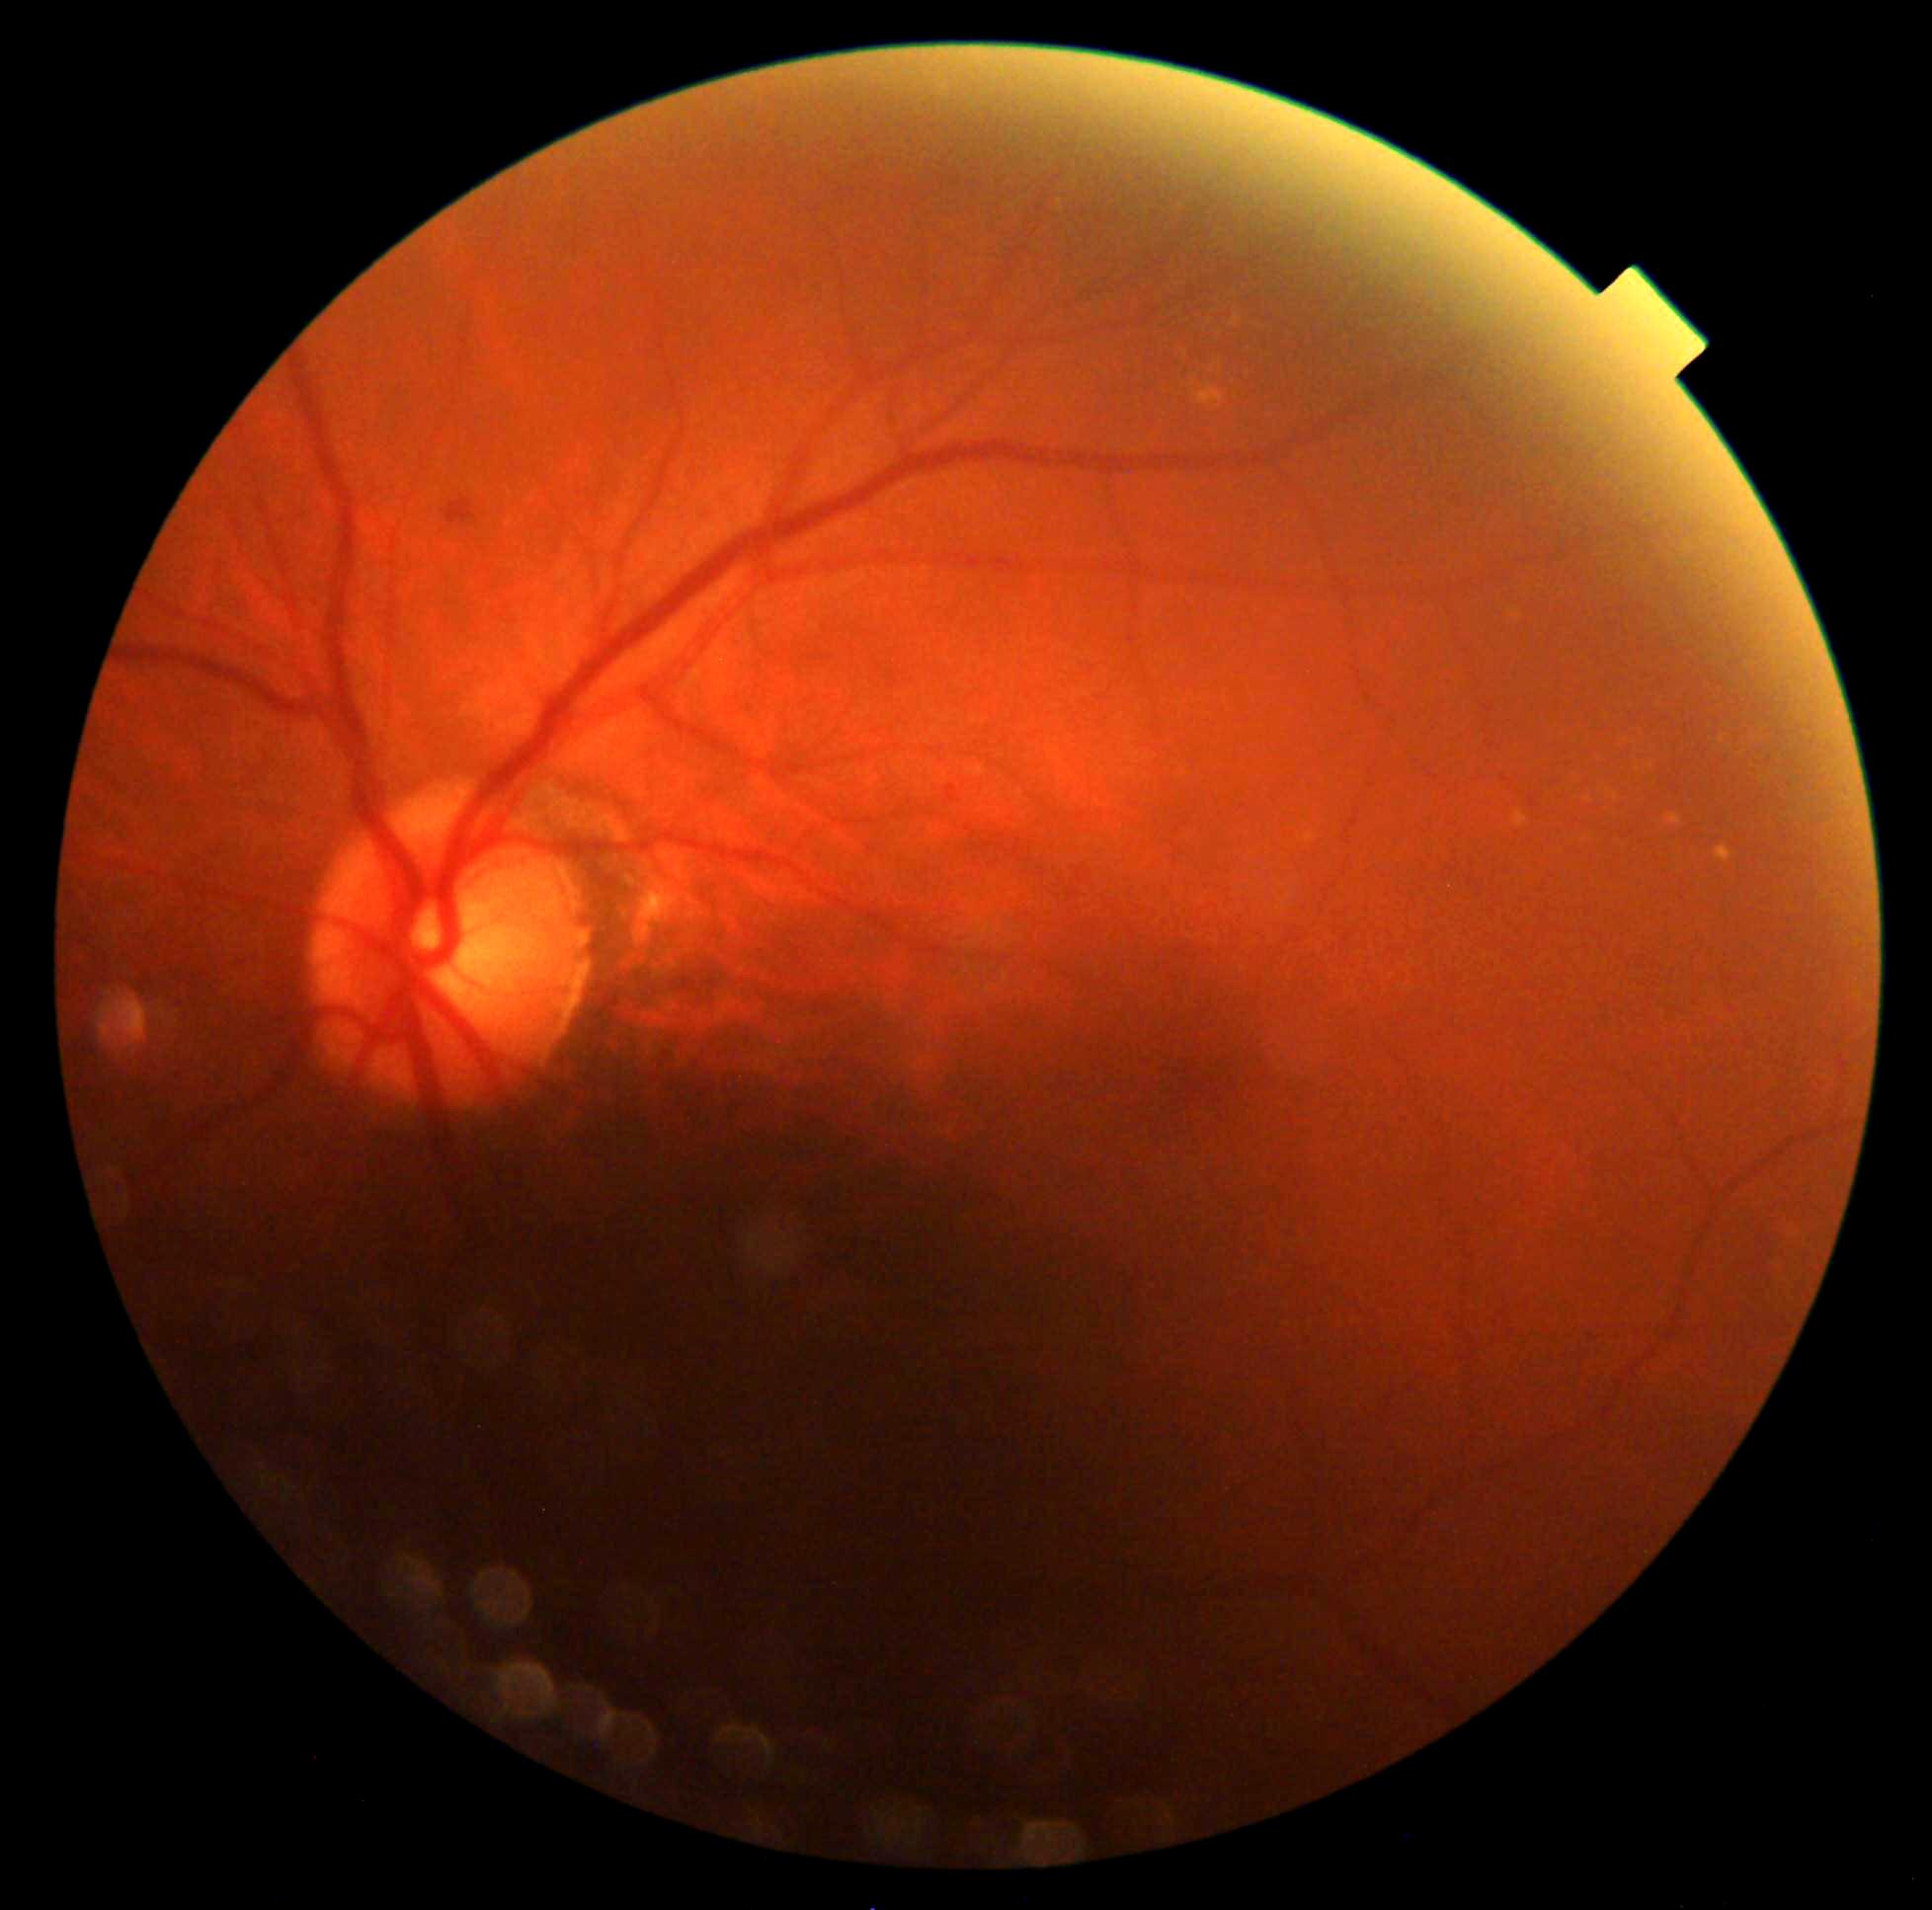
– diabetic retinopathy grade: 2 — more than just microaneurysms but less than severe NPDR